No pharmacologic dilation · NIDEK AFC-230 · diabetic retinopathy graded by the modified Davis classification
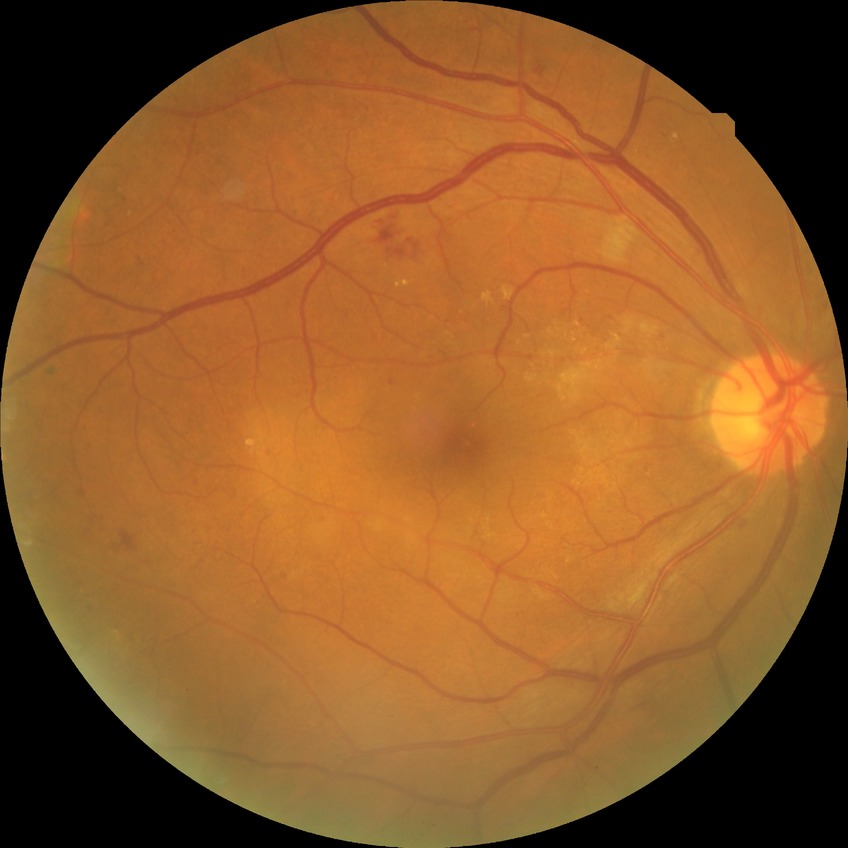

  davis_grade: PPDR (pre-proliferative diabetic retinopathy)